2048 by 1536 pixels. 45° FOV
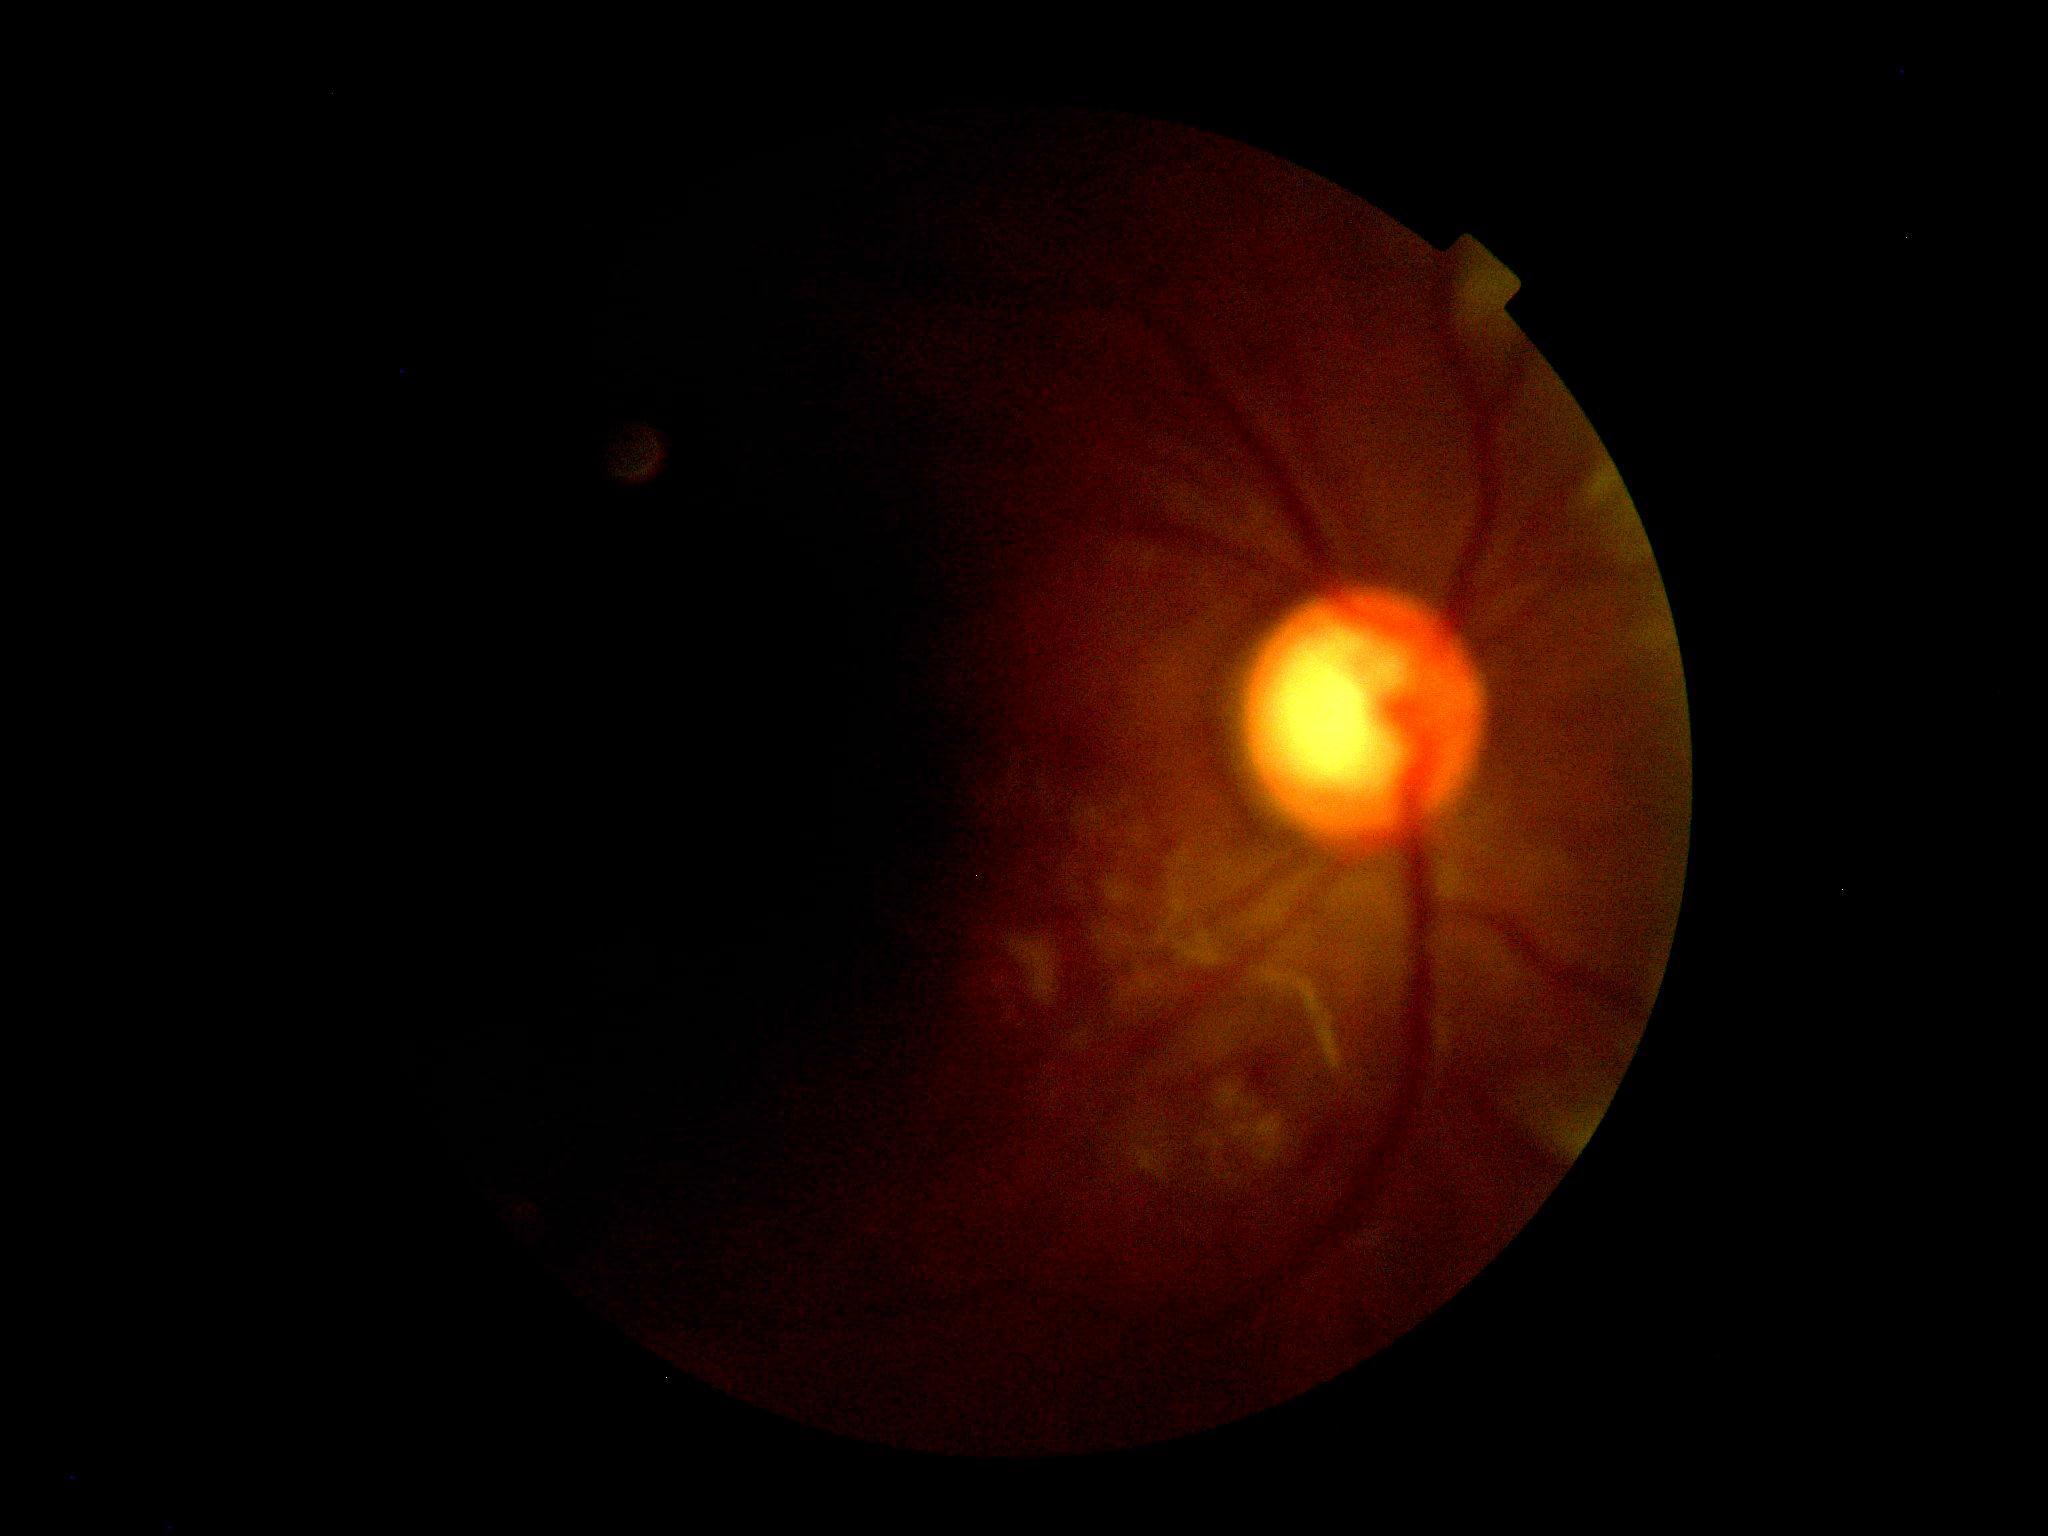
DR grade: ungradable due to poor image quality. The image cannot be graded for diabetic retinopathy.